Modified Davis classification.
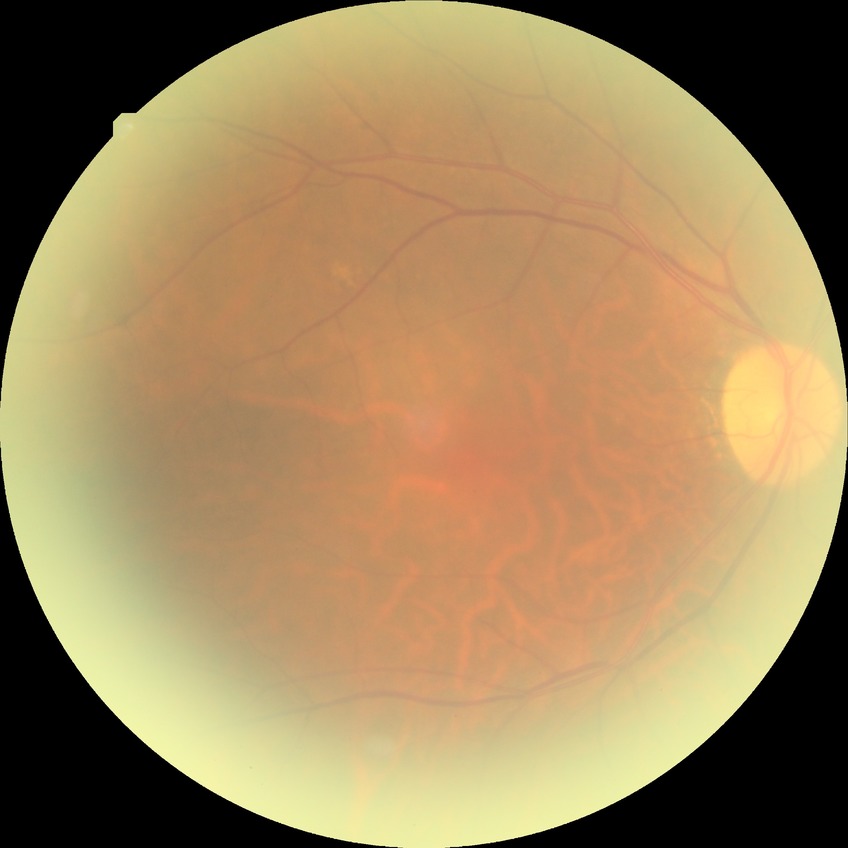   davis_grade: no diabetic retinopathy (NDR)